Color fundus photograph · nonmydriatic fundus photograph
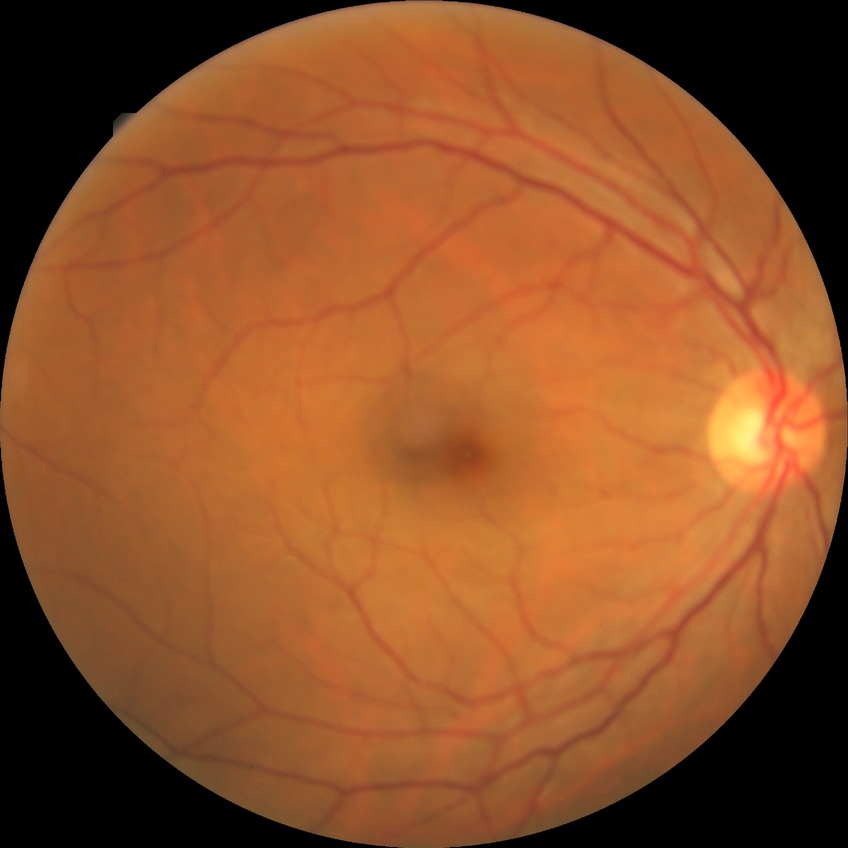 Diabetic retinopathy (DR): simple diabetic retinopathy (SDR).
Disease class: non-proliferative diabetic retinopathy.